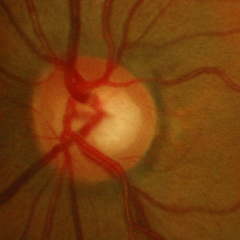
No glaucoma.